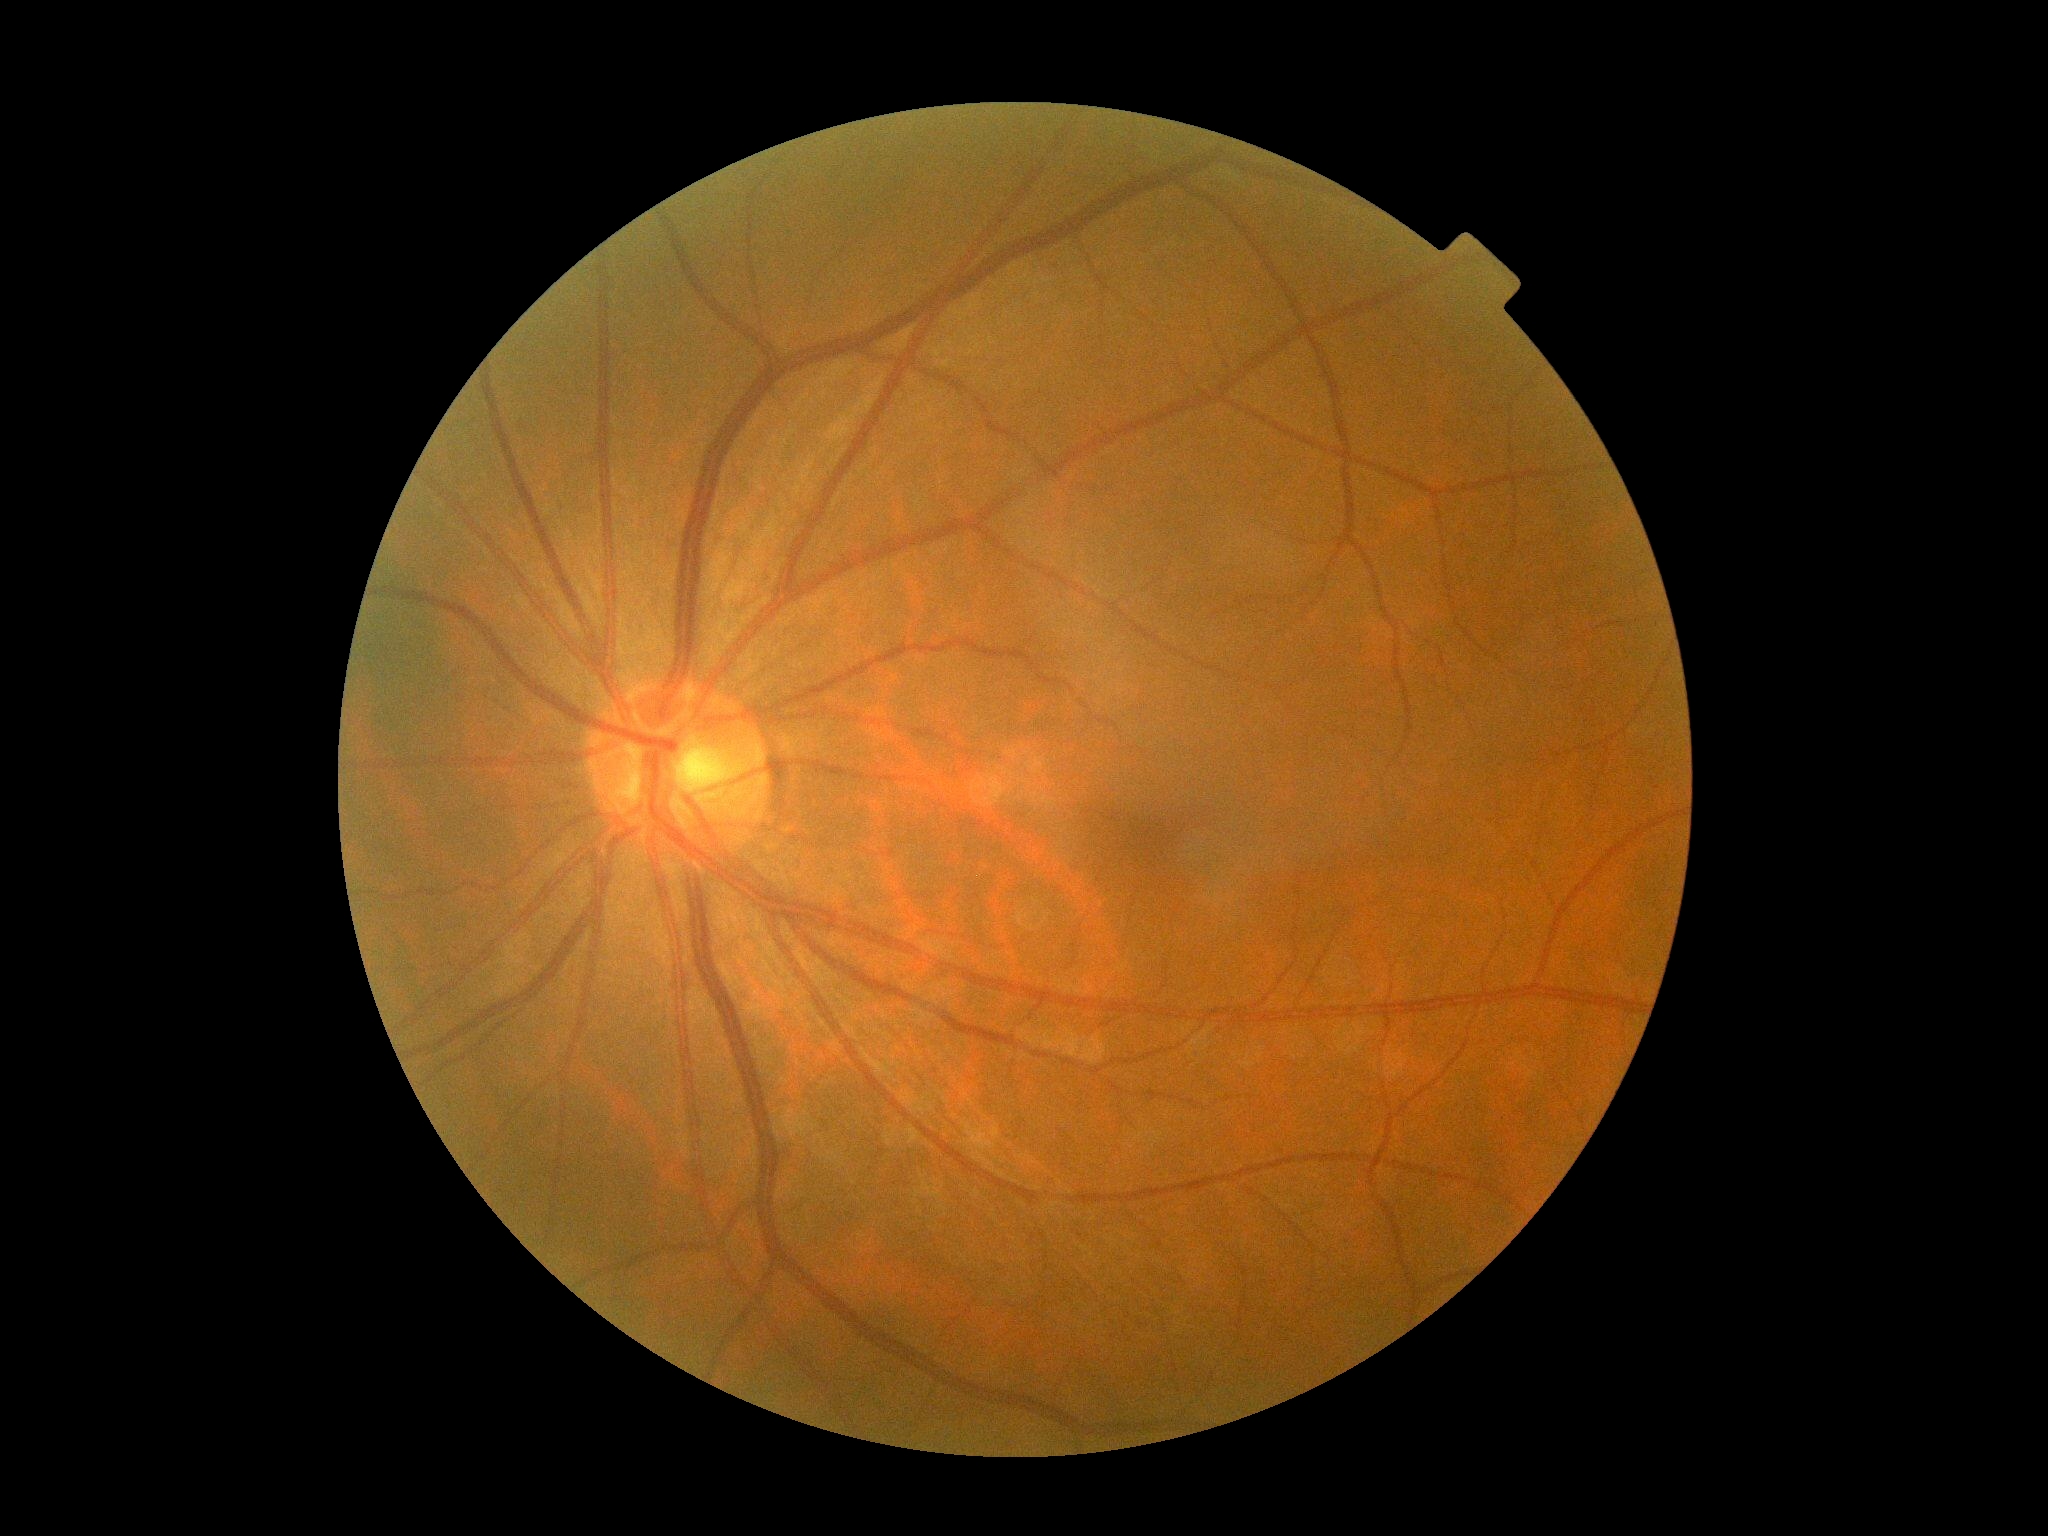 Diabetic retinopathy (DR): grade 0 (no apparent retinopathy) — no visible signs of diabetic retinopathy. No DR findings.